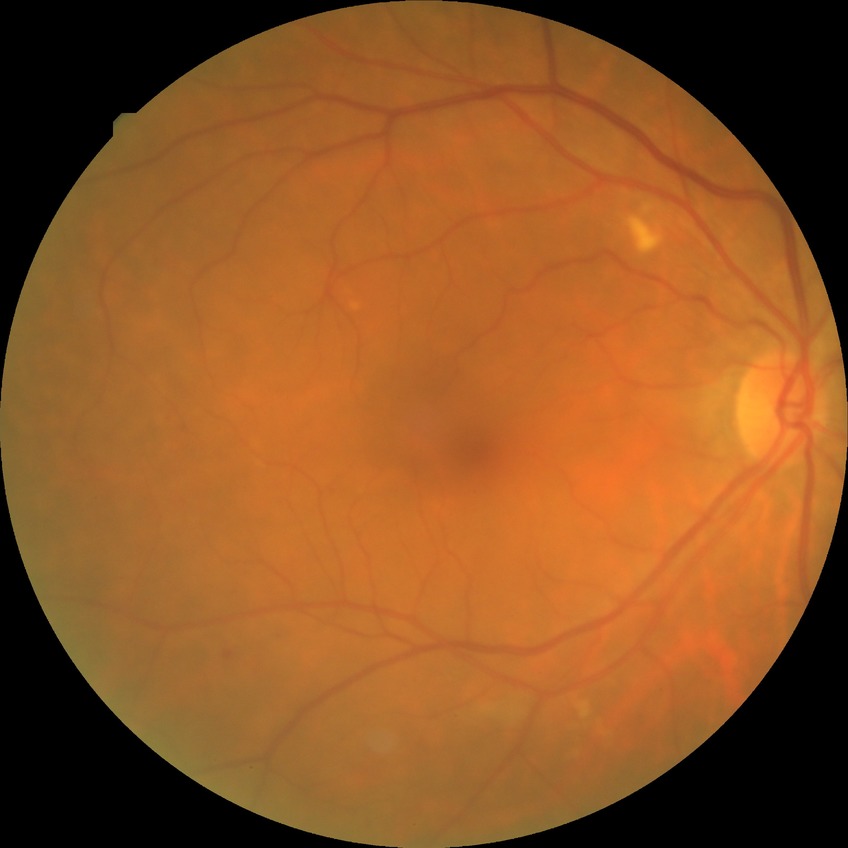
Modified Davis grade is SDR.